Cropped to the optic nerve head.
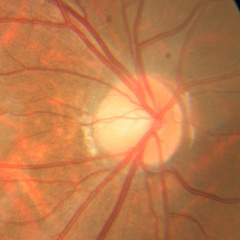

Glaucoma diagnosis = no glaucomatous optic neuropathy.